2361 by 1568 pixels, color fundus photograph:
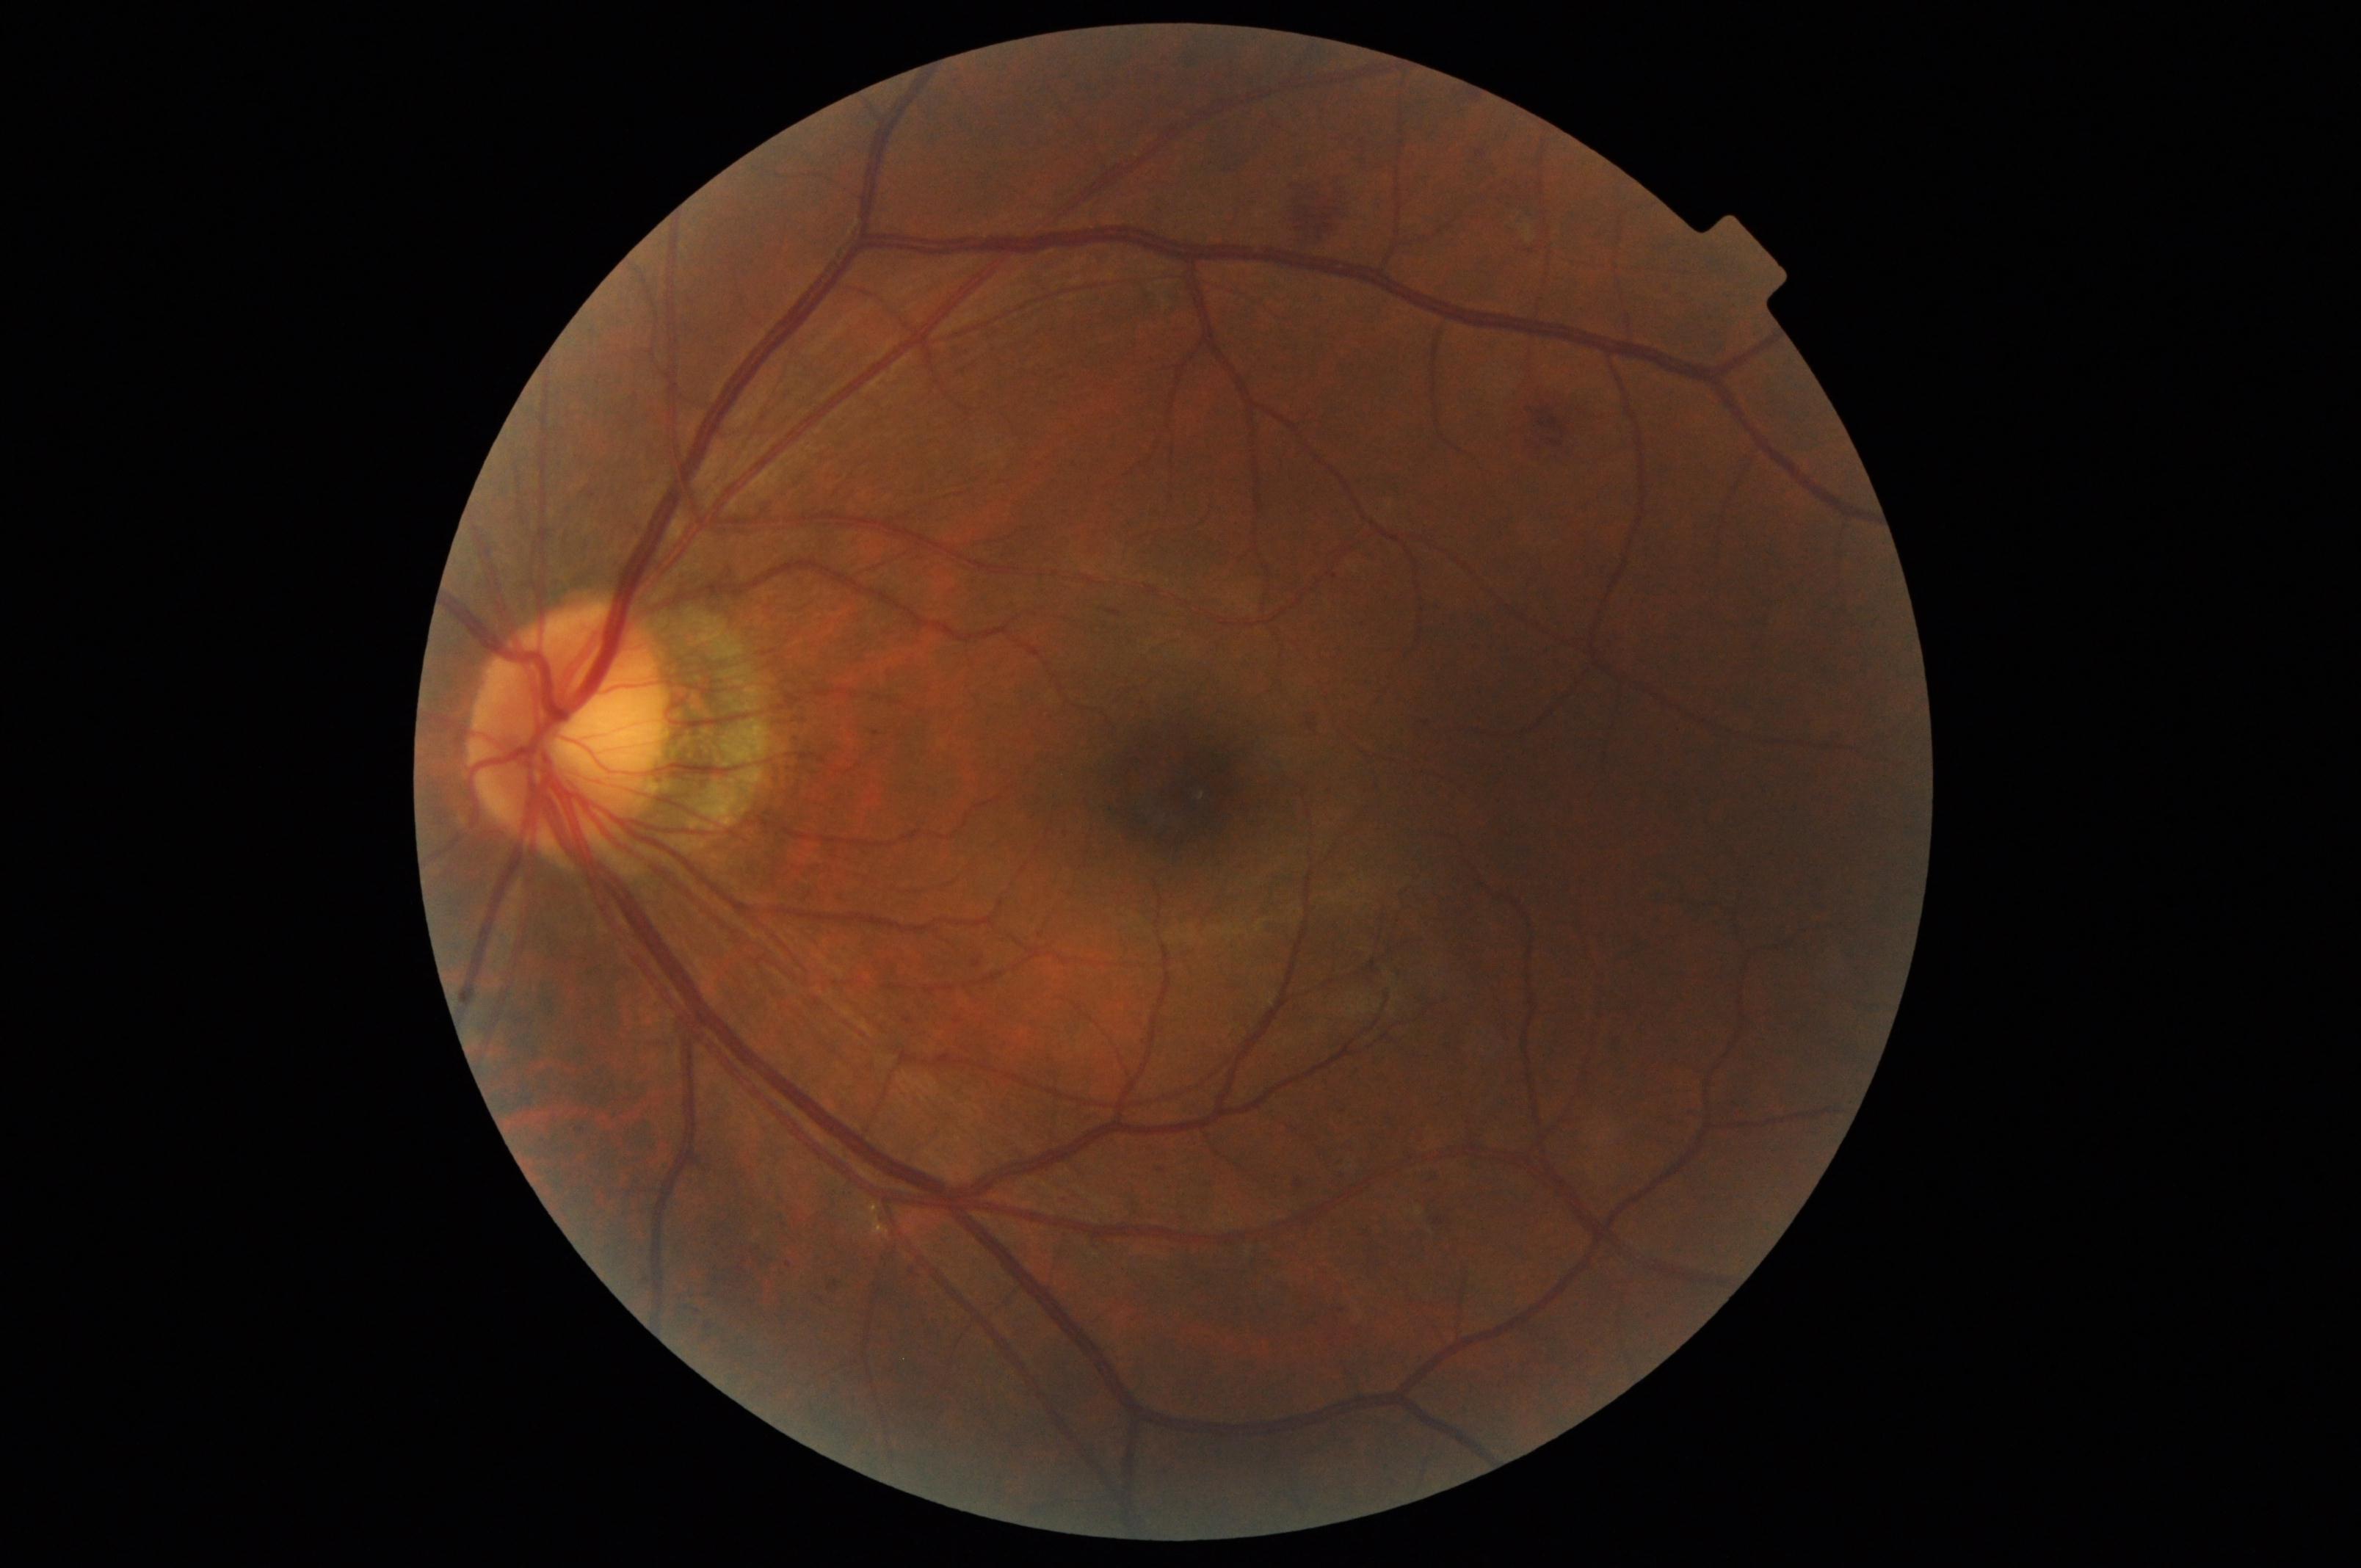

Diabetic retinopathy: moderate non-proliferative diabetic retinopathy (grade 2).